45-degree field of view.
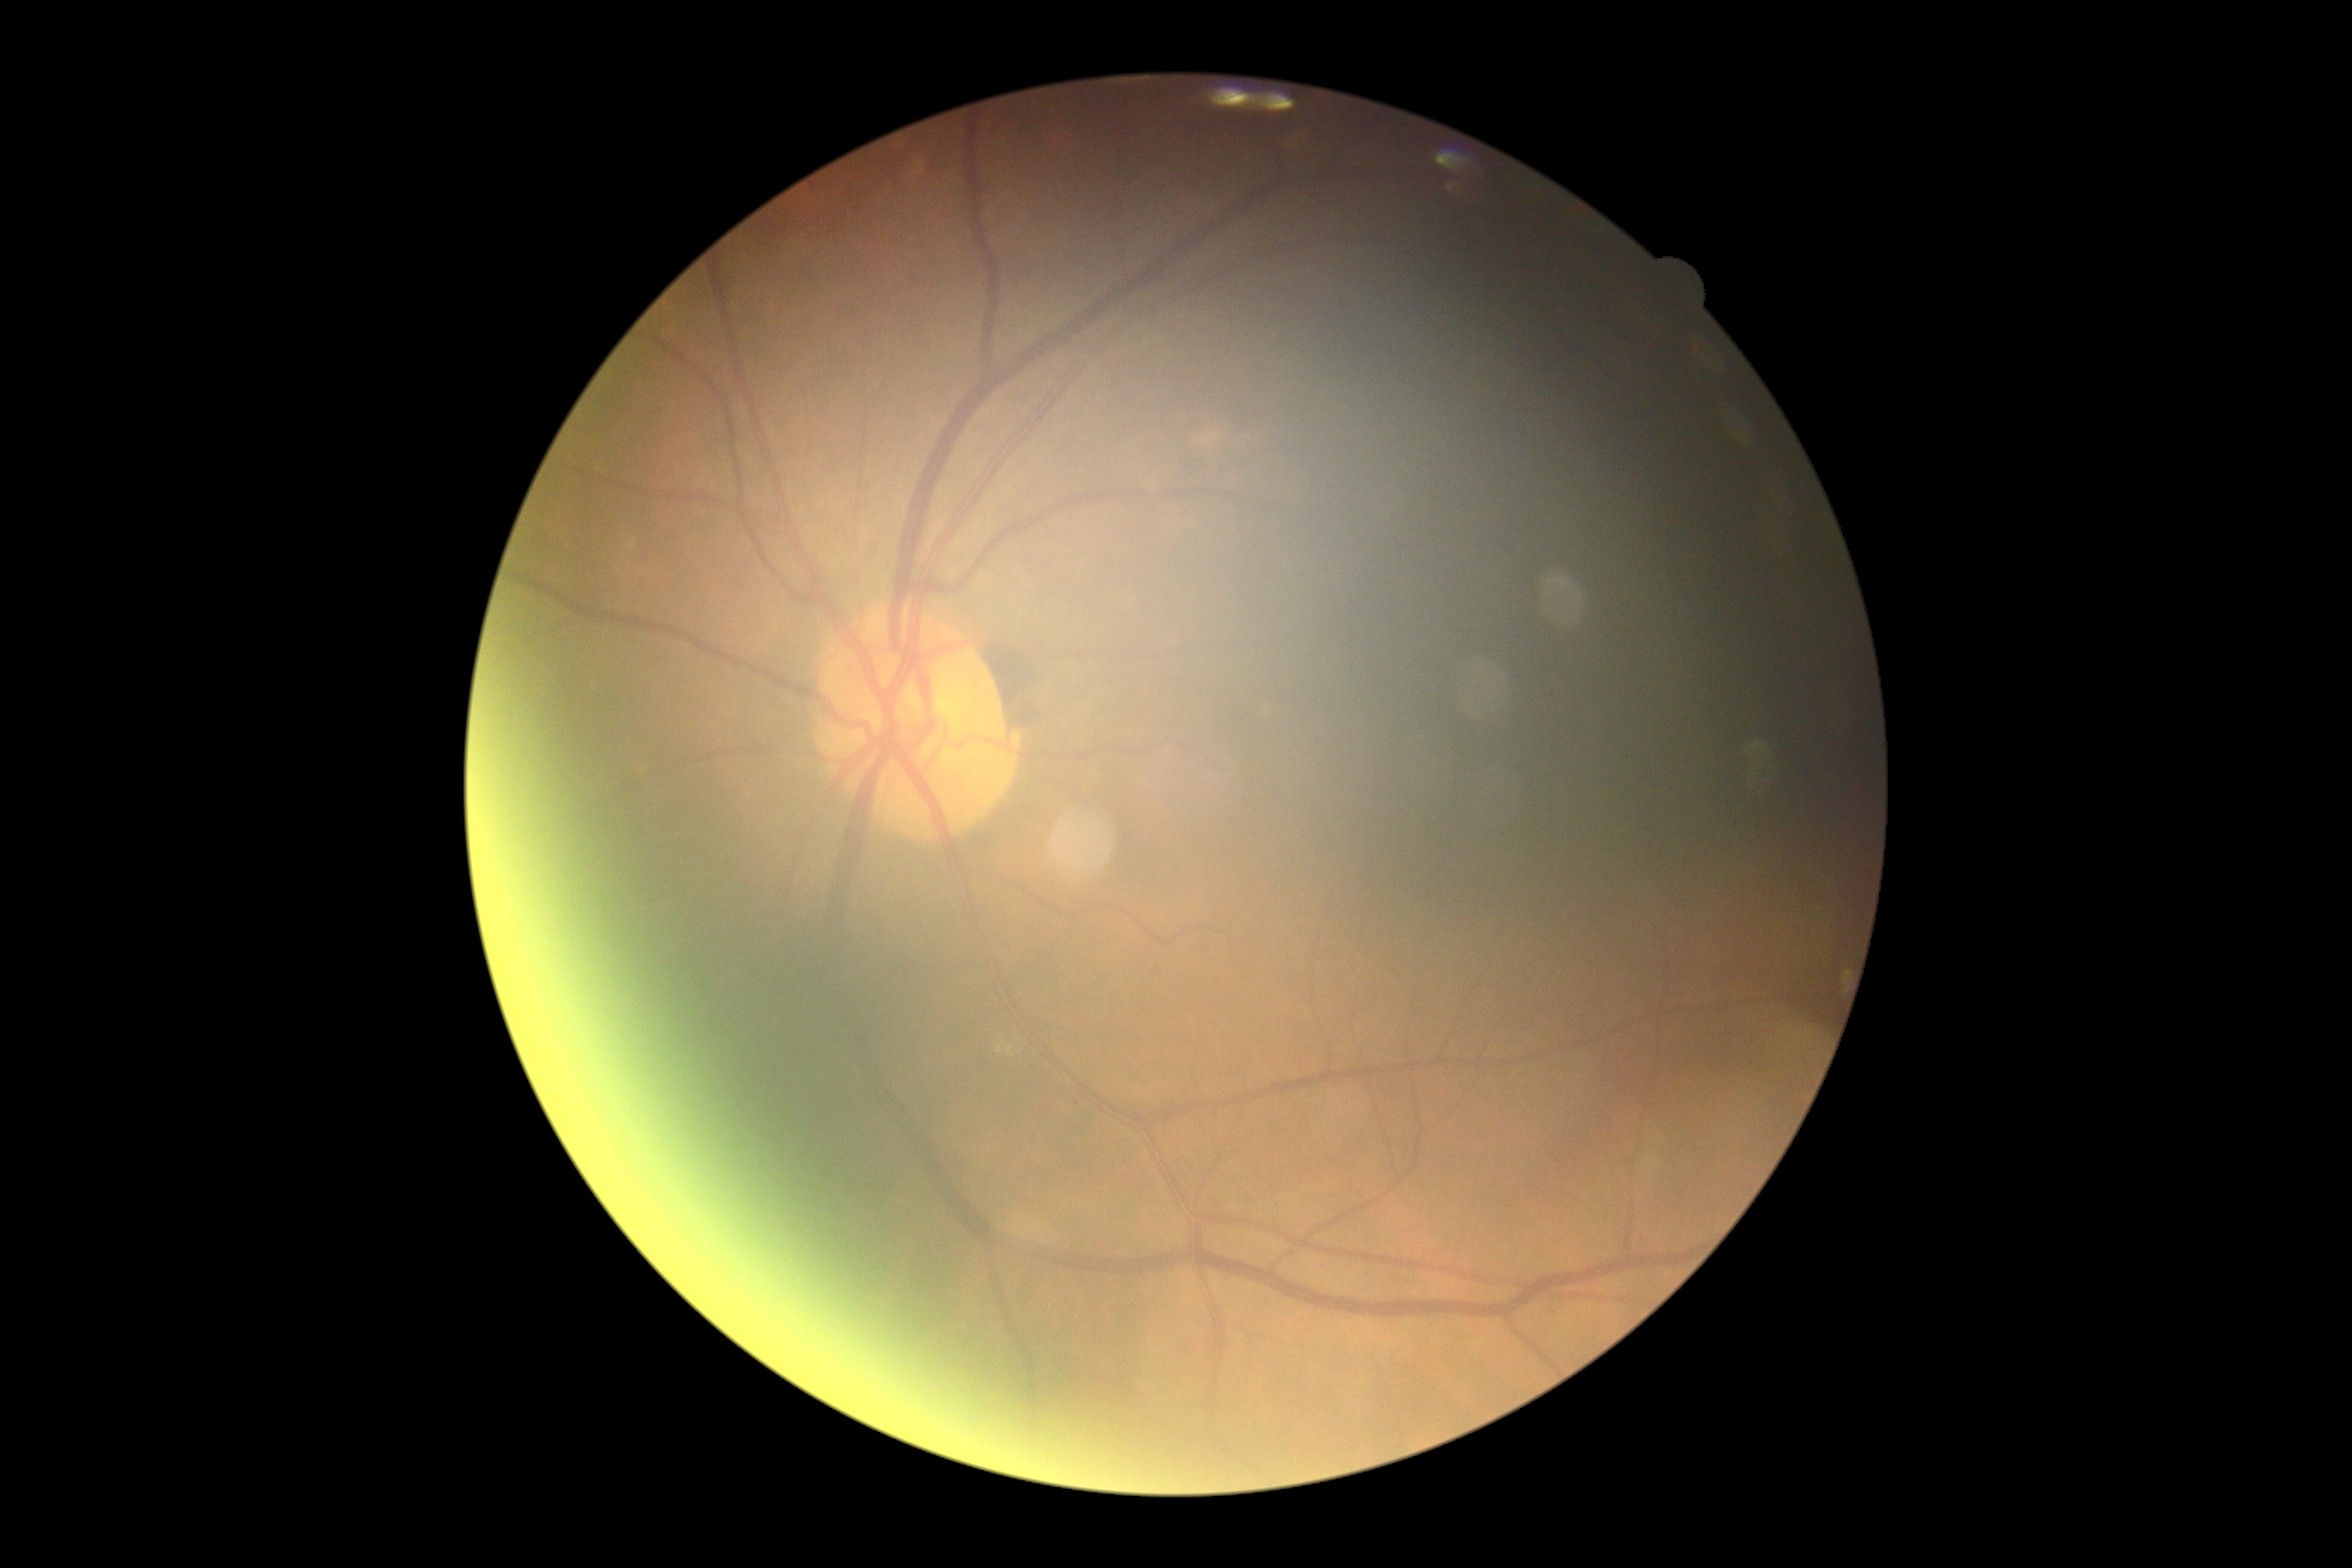

Retinopathy: 0.